848x848 · 45 degree fundus photograph
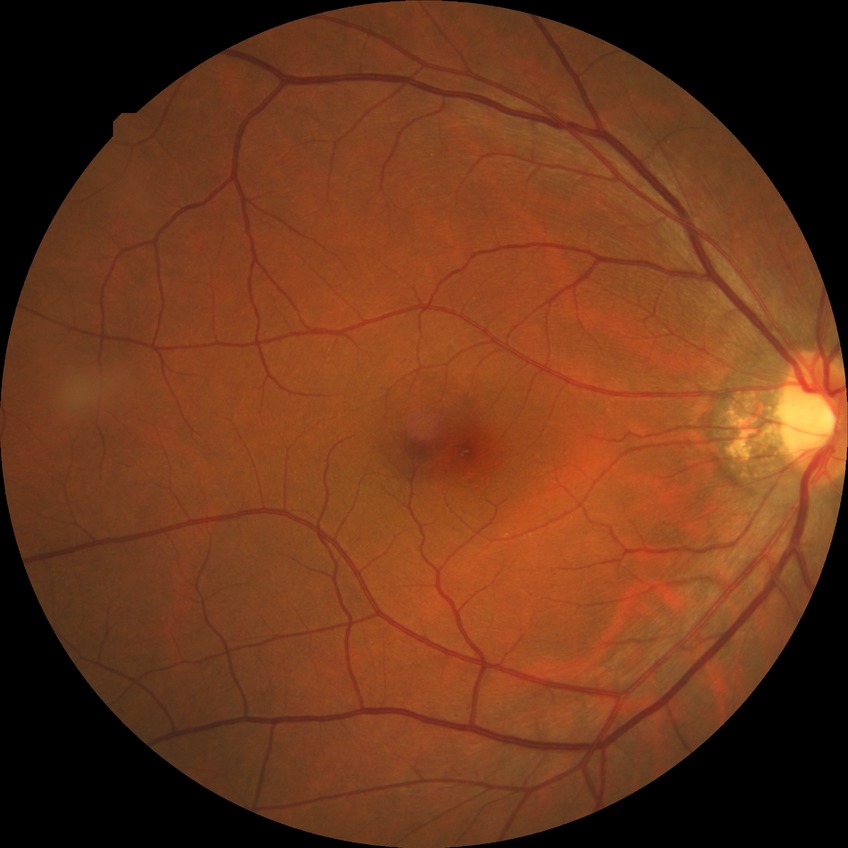 Retinopathy stage: no diabetic retinopathy.